45° FOV; NIDEK AFC-230 fundus camera
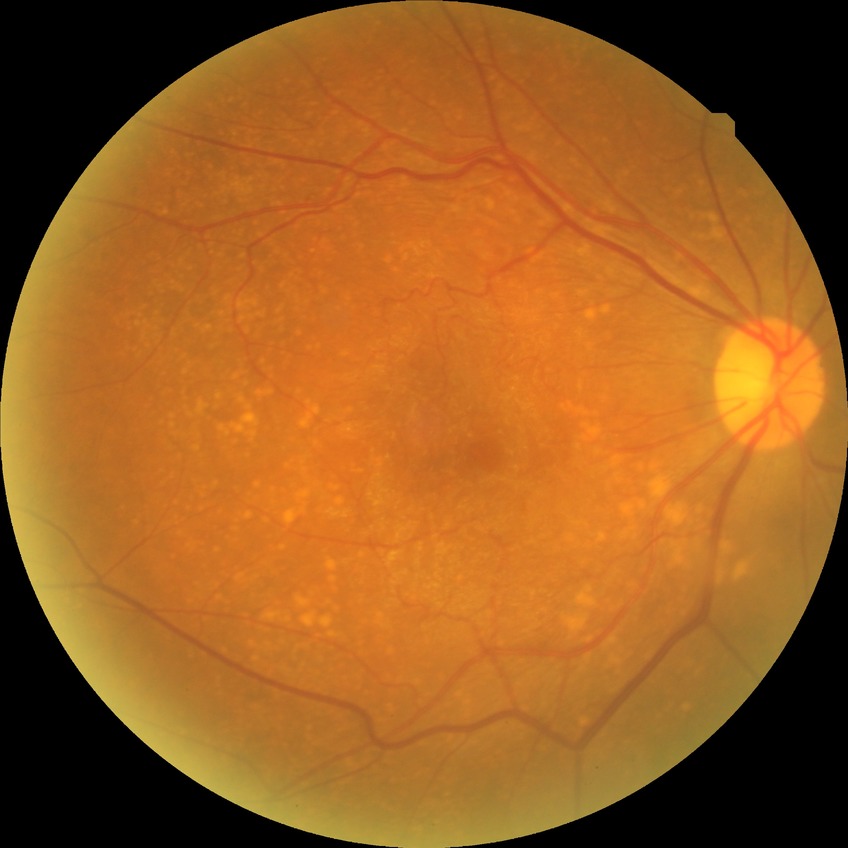

Davis DR grade is NDR.